2352 by 1568 pixels: 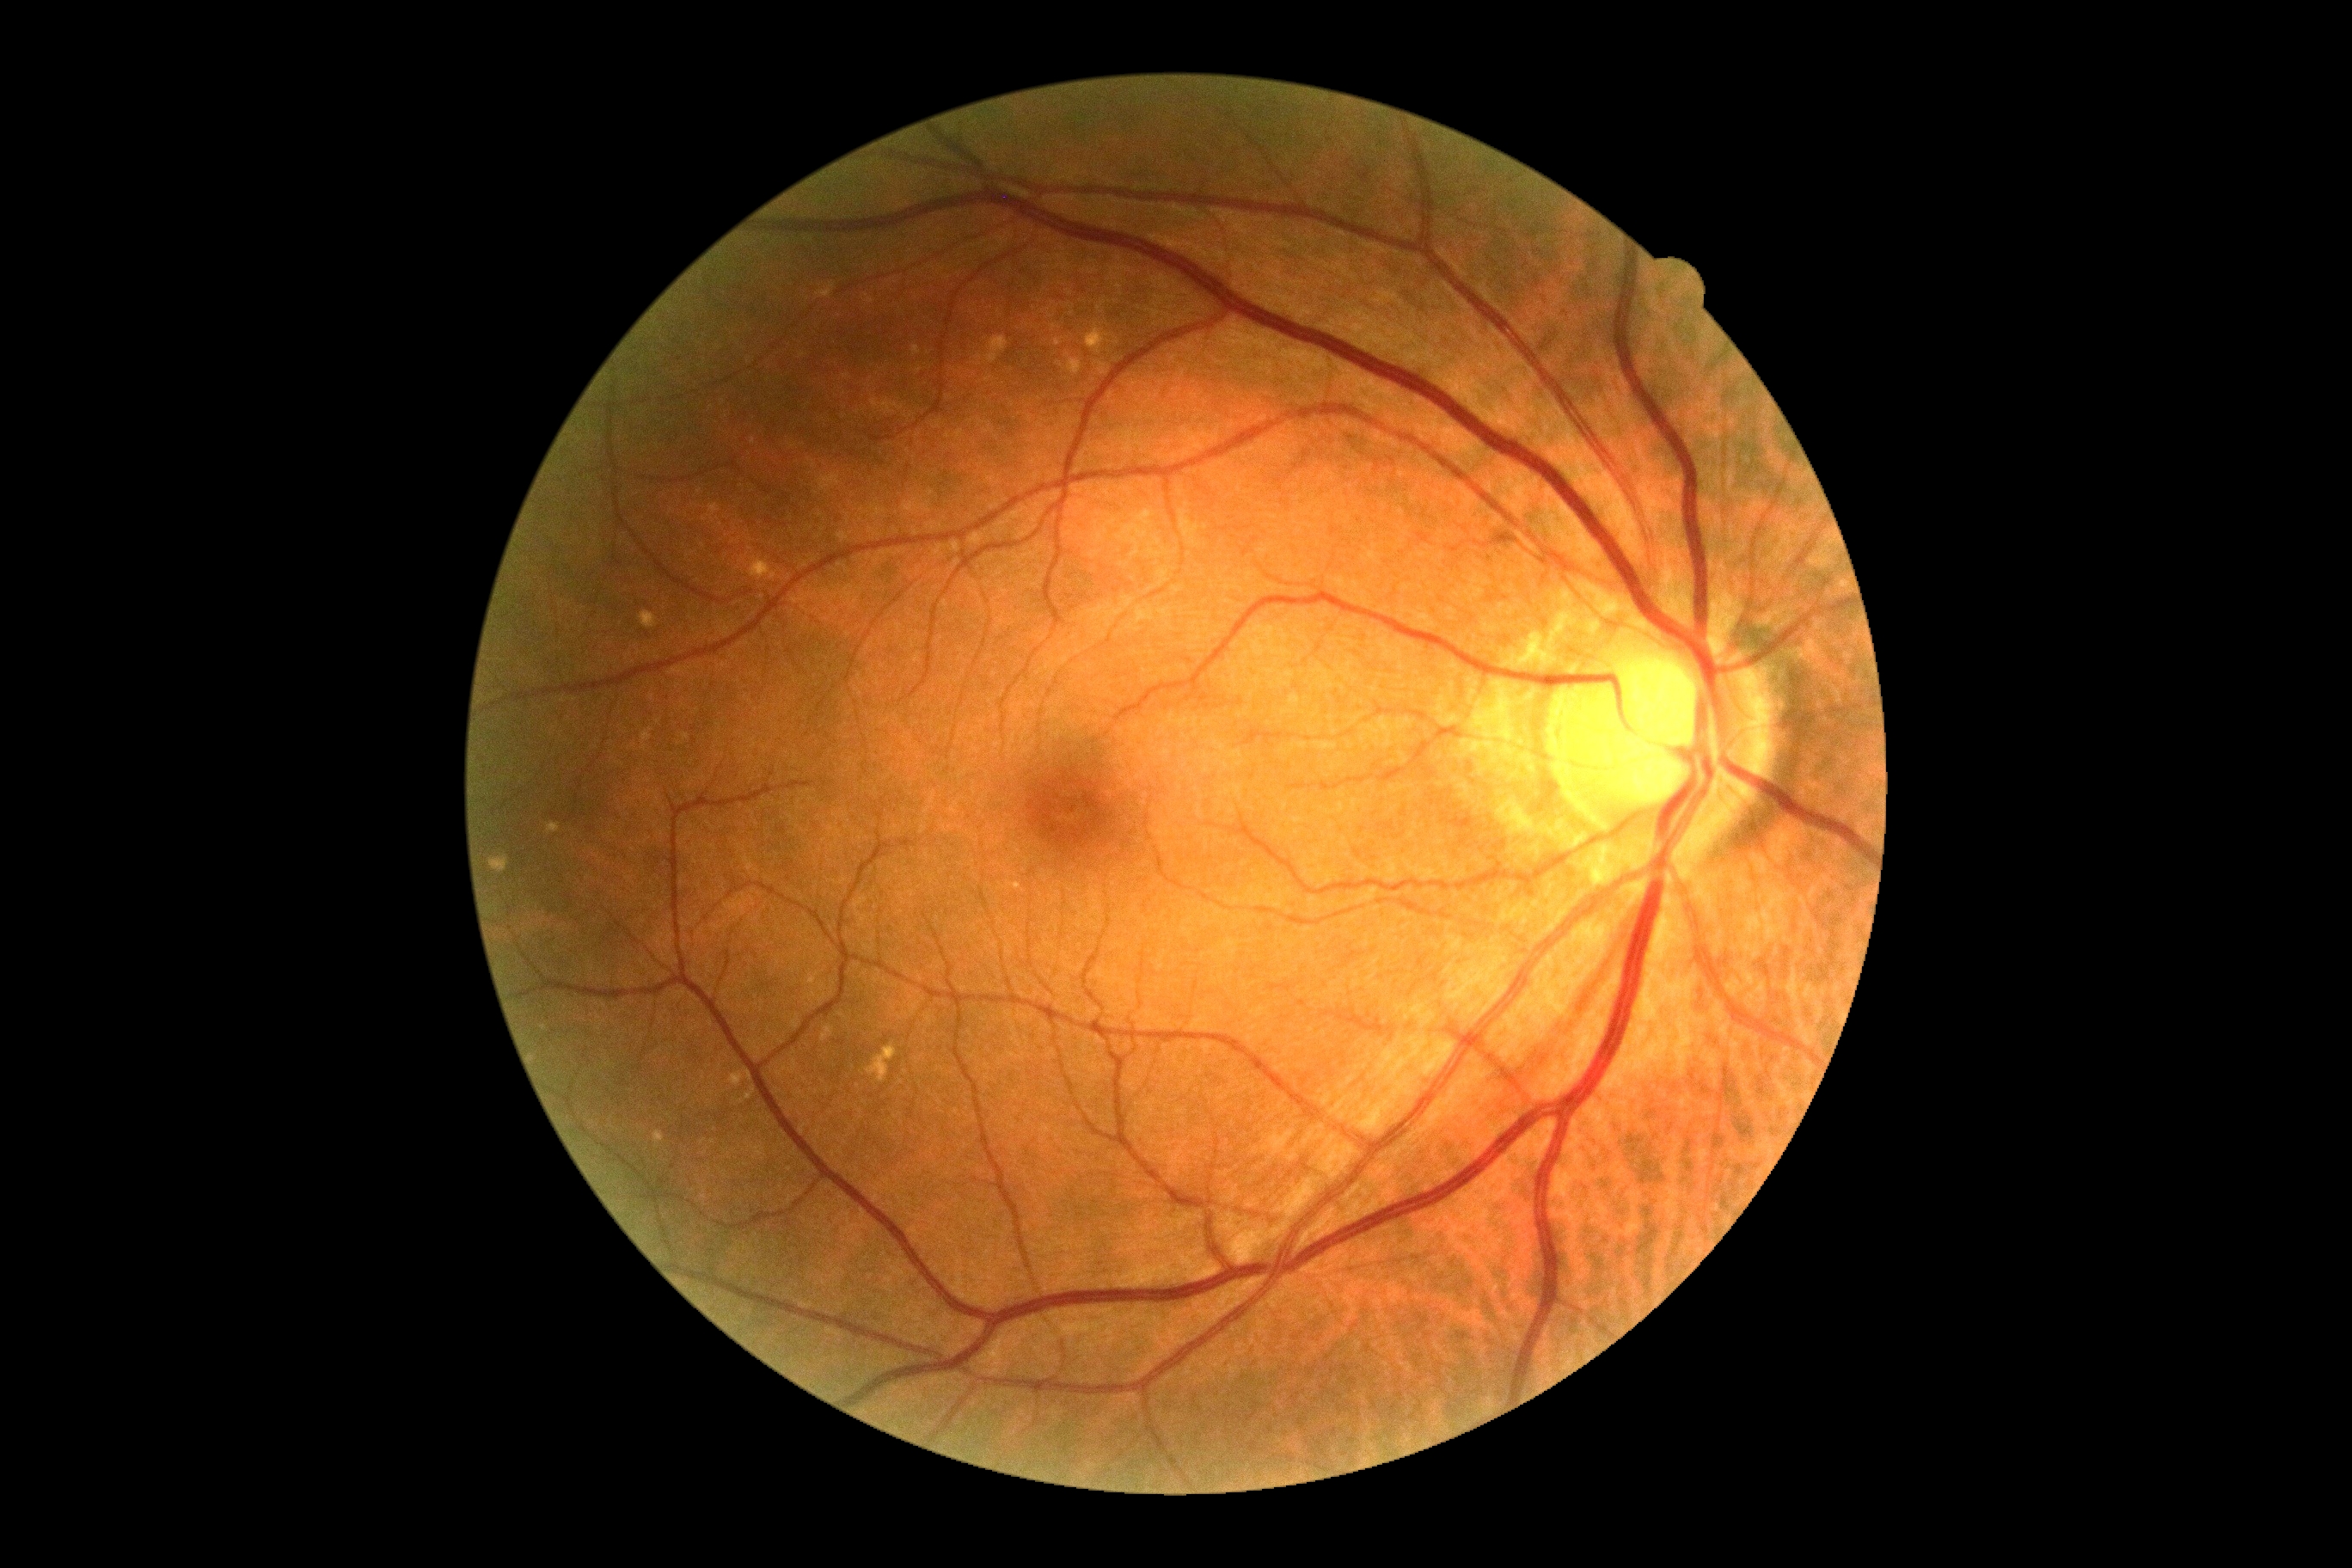
DR grade: 0 (no apparent retinopathy).
No diabetic retinal disease findings.